Image size 1659x2212. Captured on a Remidio Fundus on Phone
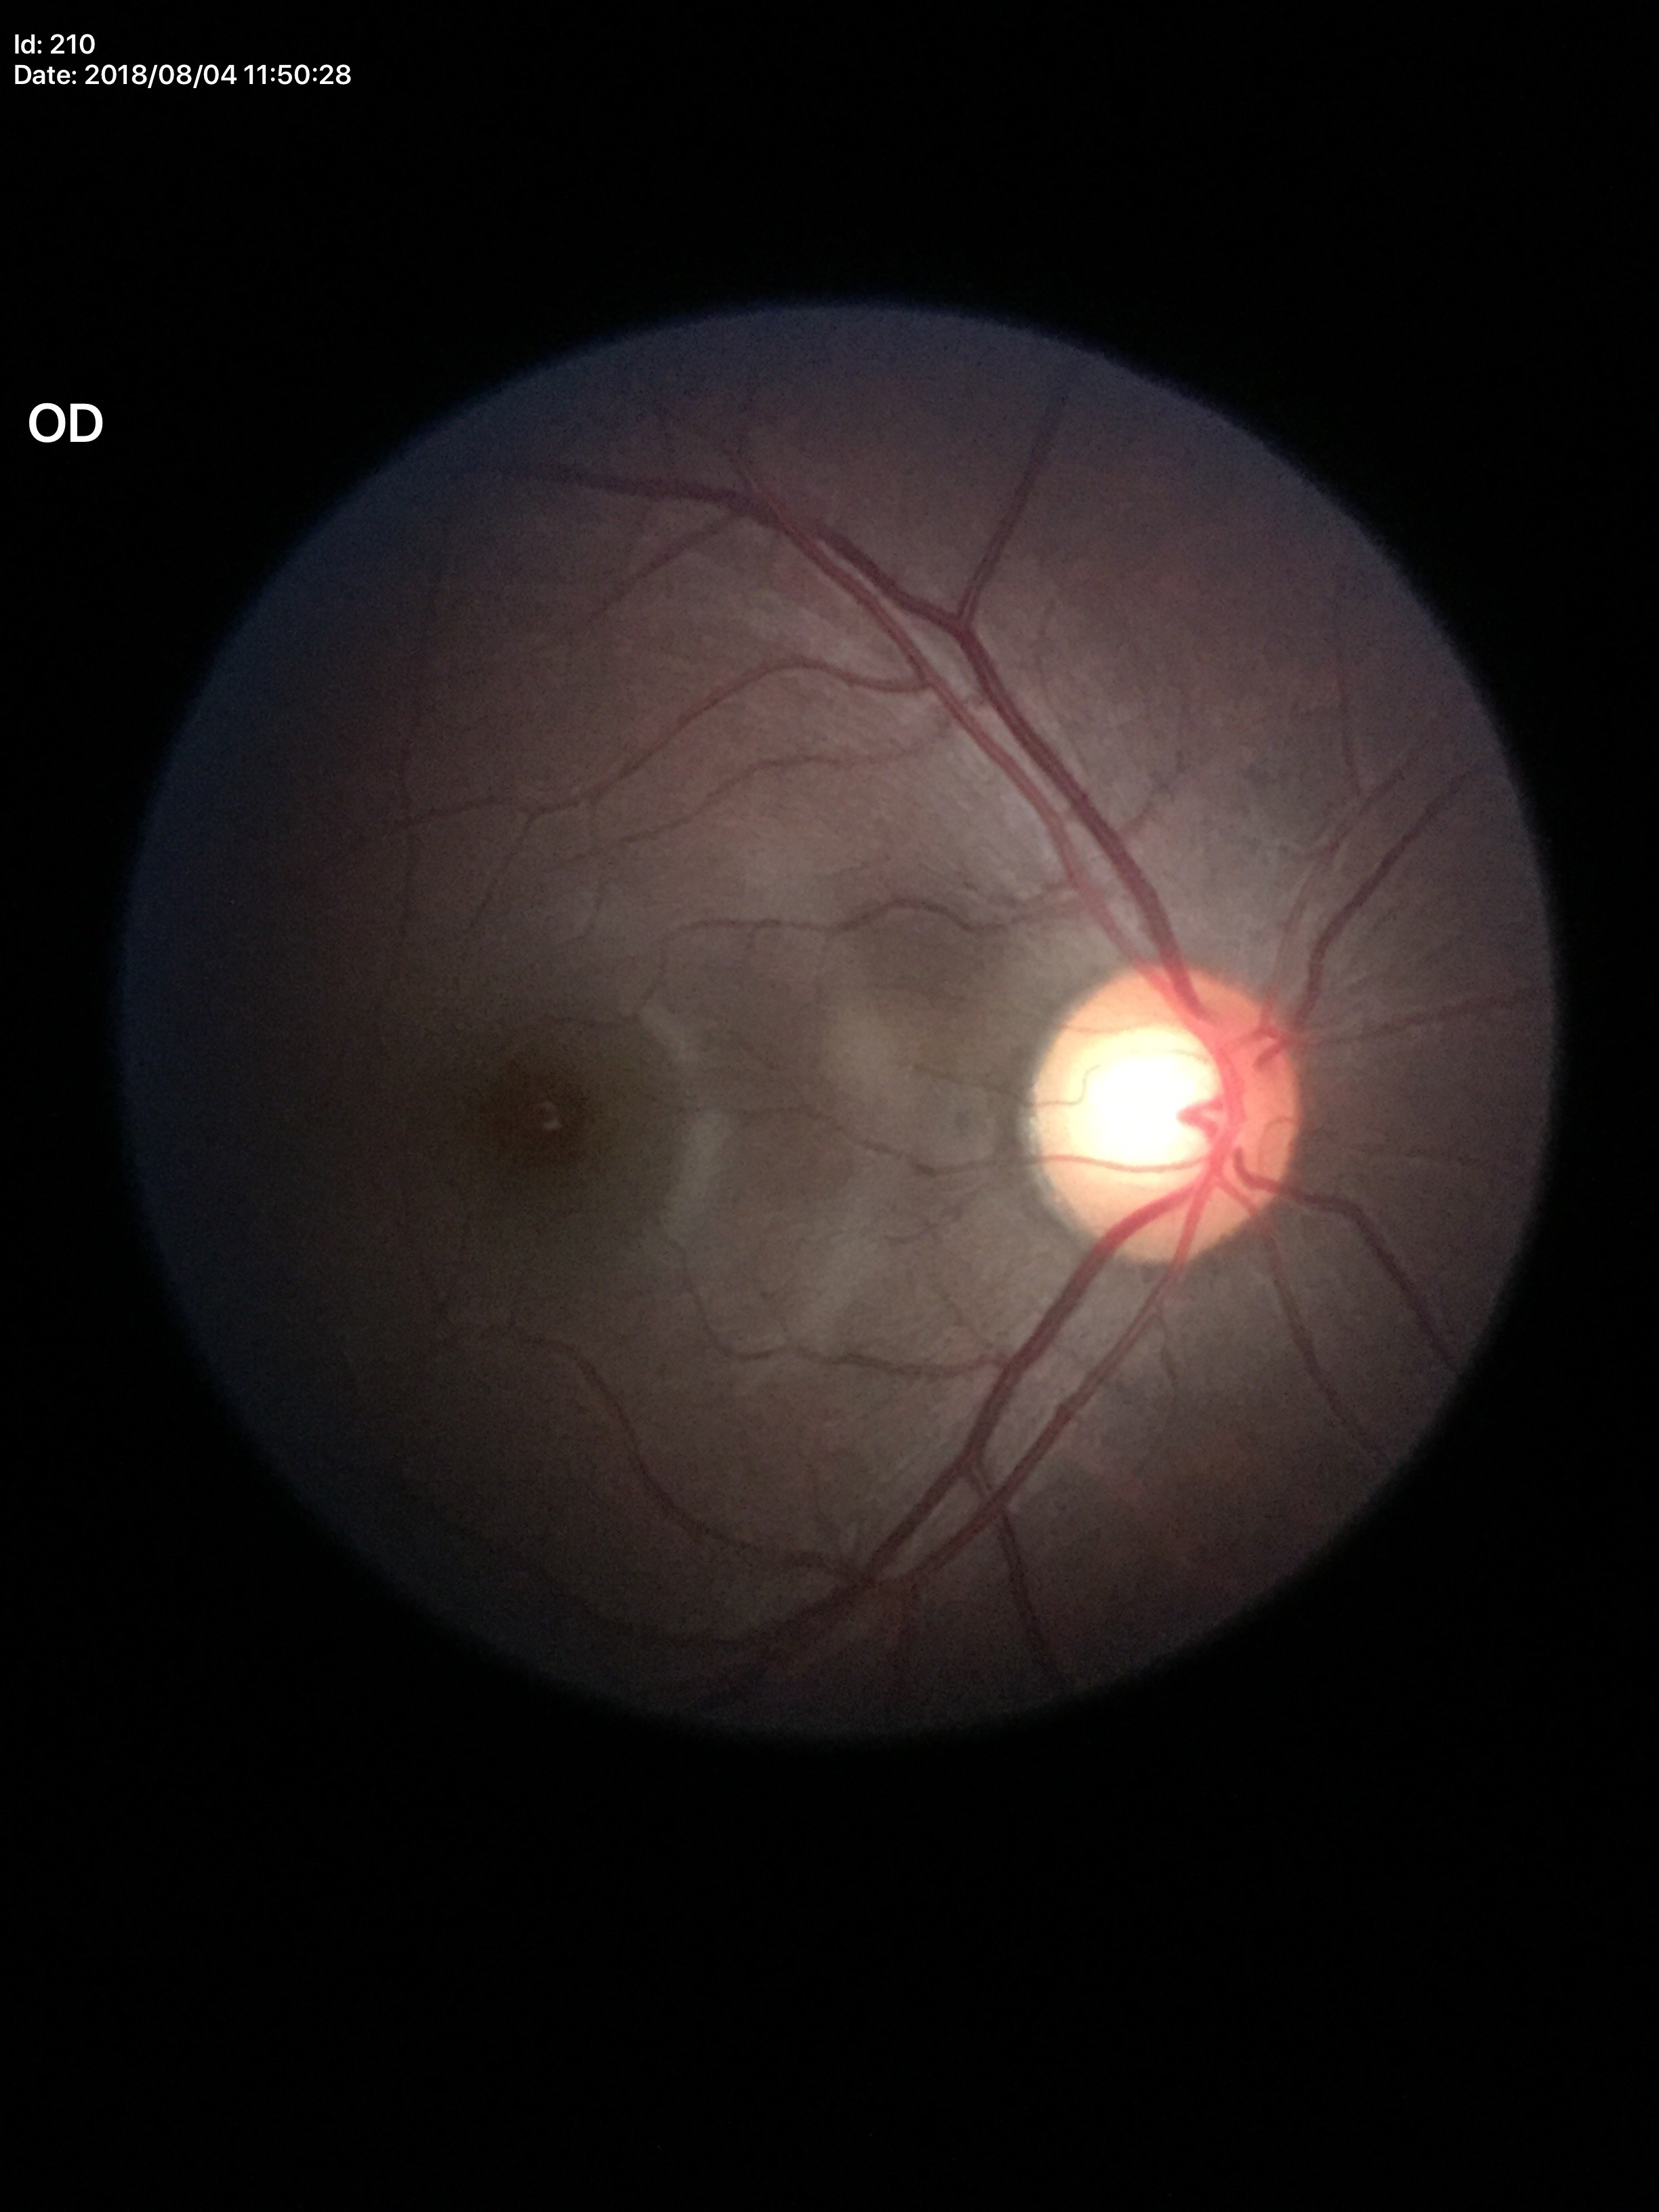
  glaucoma_decision: suspicious findings
  vcdr: 0.62